CFP; 2352 x 1568 pixels — 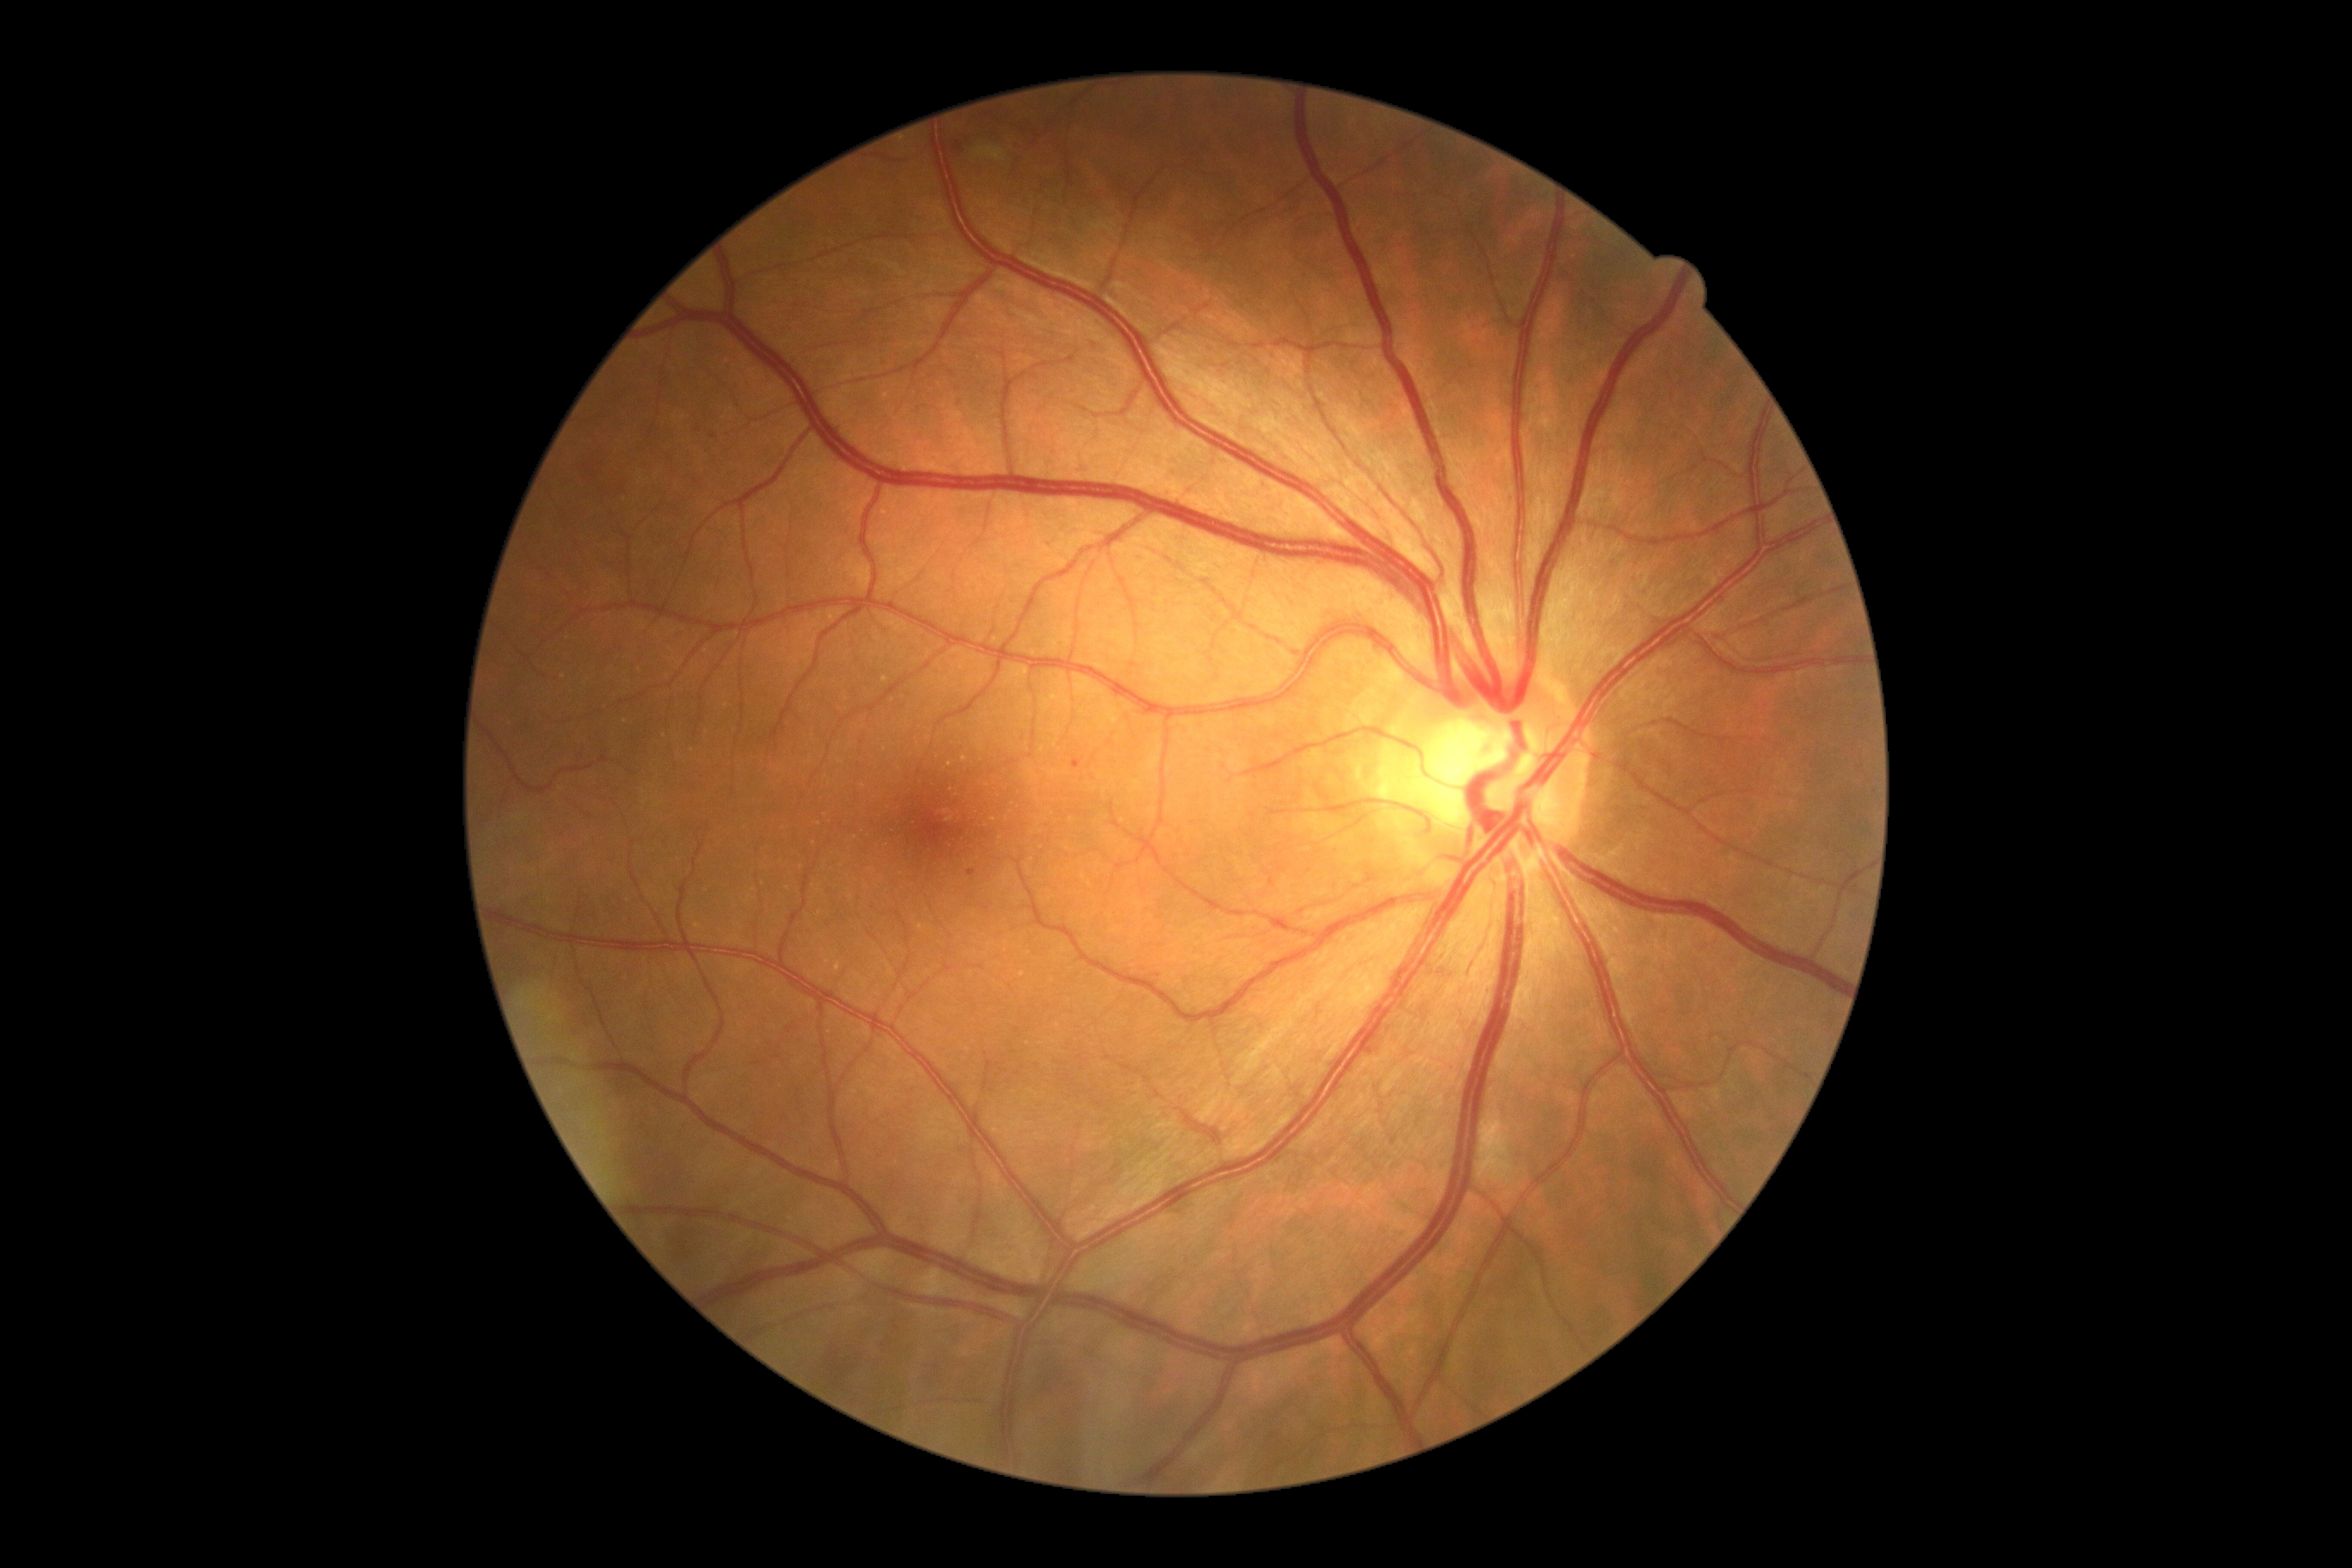
DR: 1/4 — presence of microaneurysms only
Findings:
* EXs: none
* HEs: (left=950, top=135, right=971, bottom=150)
* SEs: (left=972, top=147, right=1007, bottom=162)
* MAs: (left=1072, top=761, right=1082, bottom=769)
* Additional small MAs near (972; 874)